45-degree field of view, 1932 by 1916 pixels: 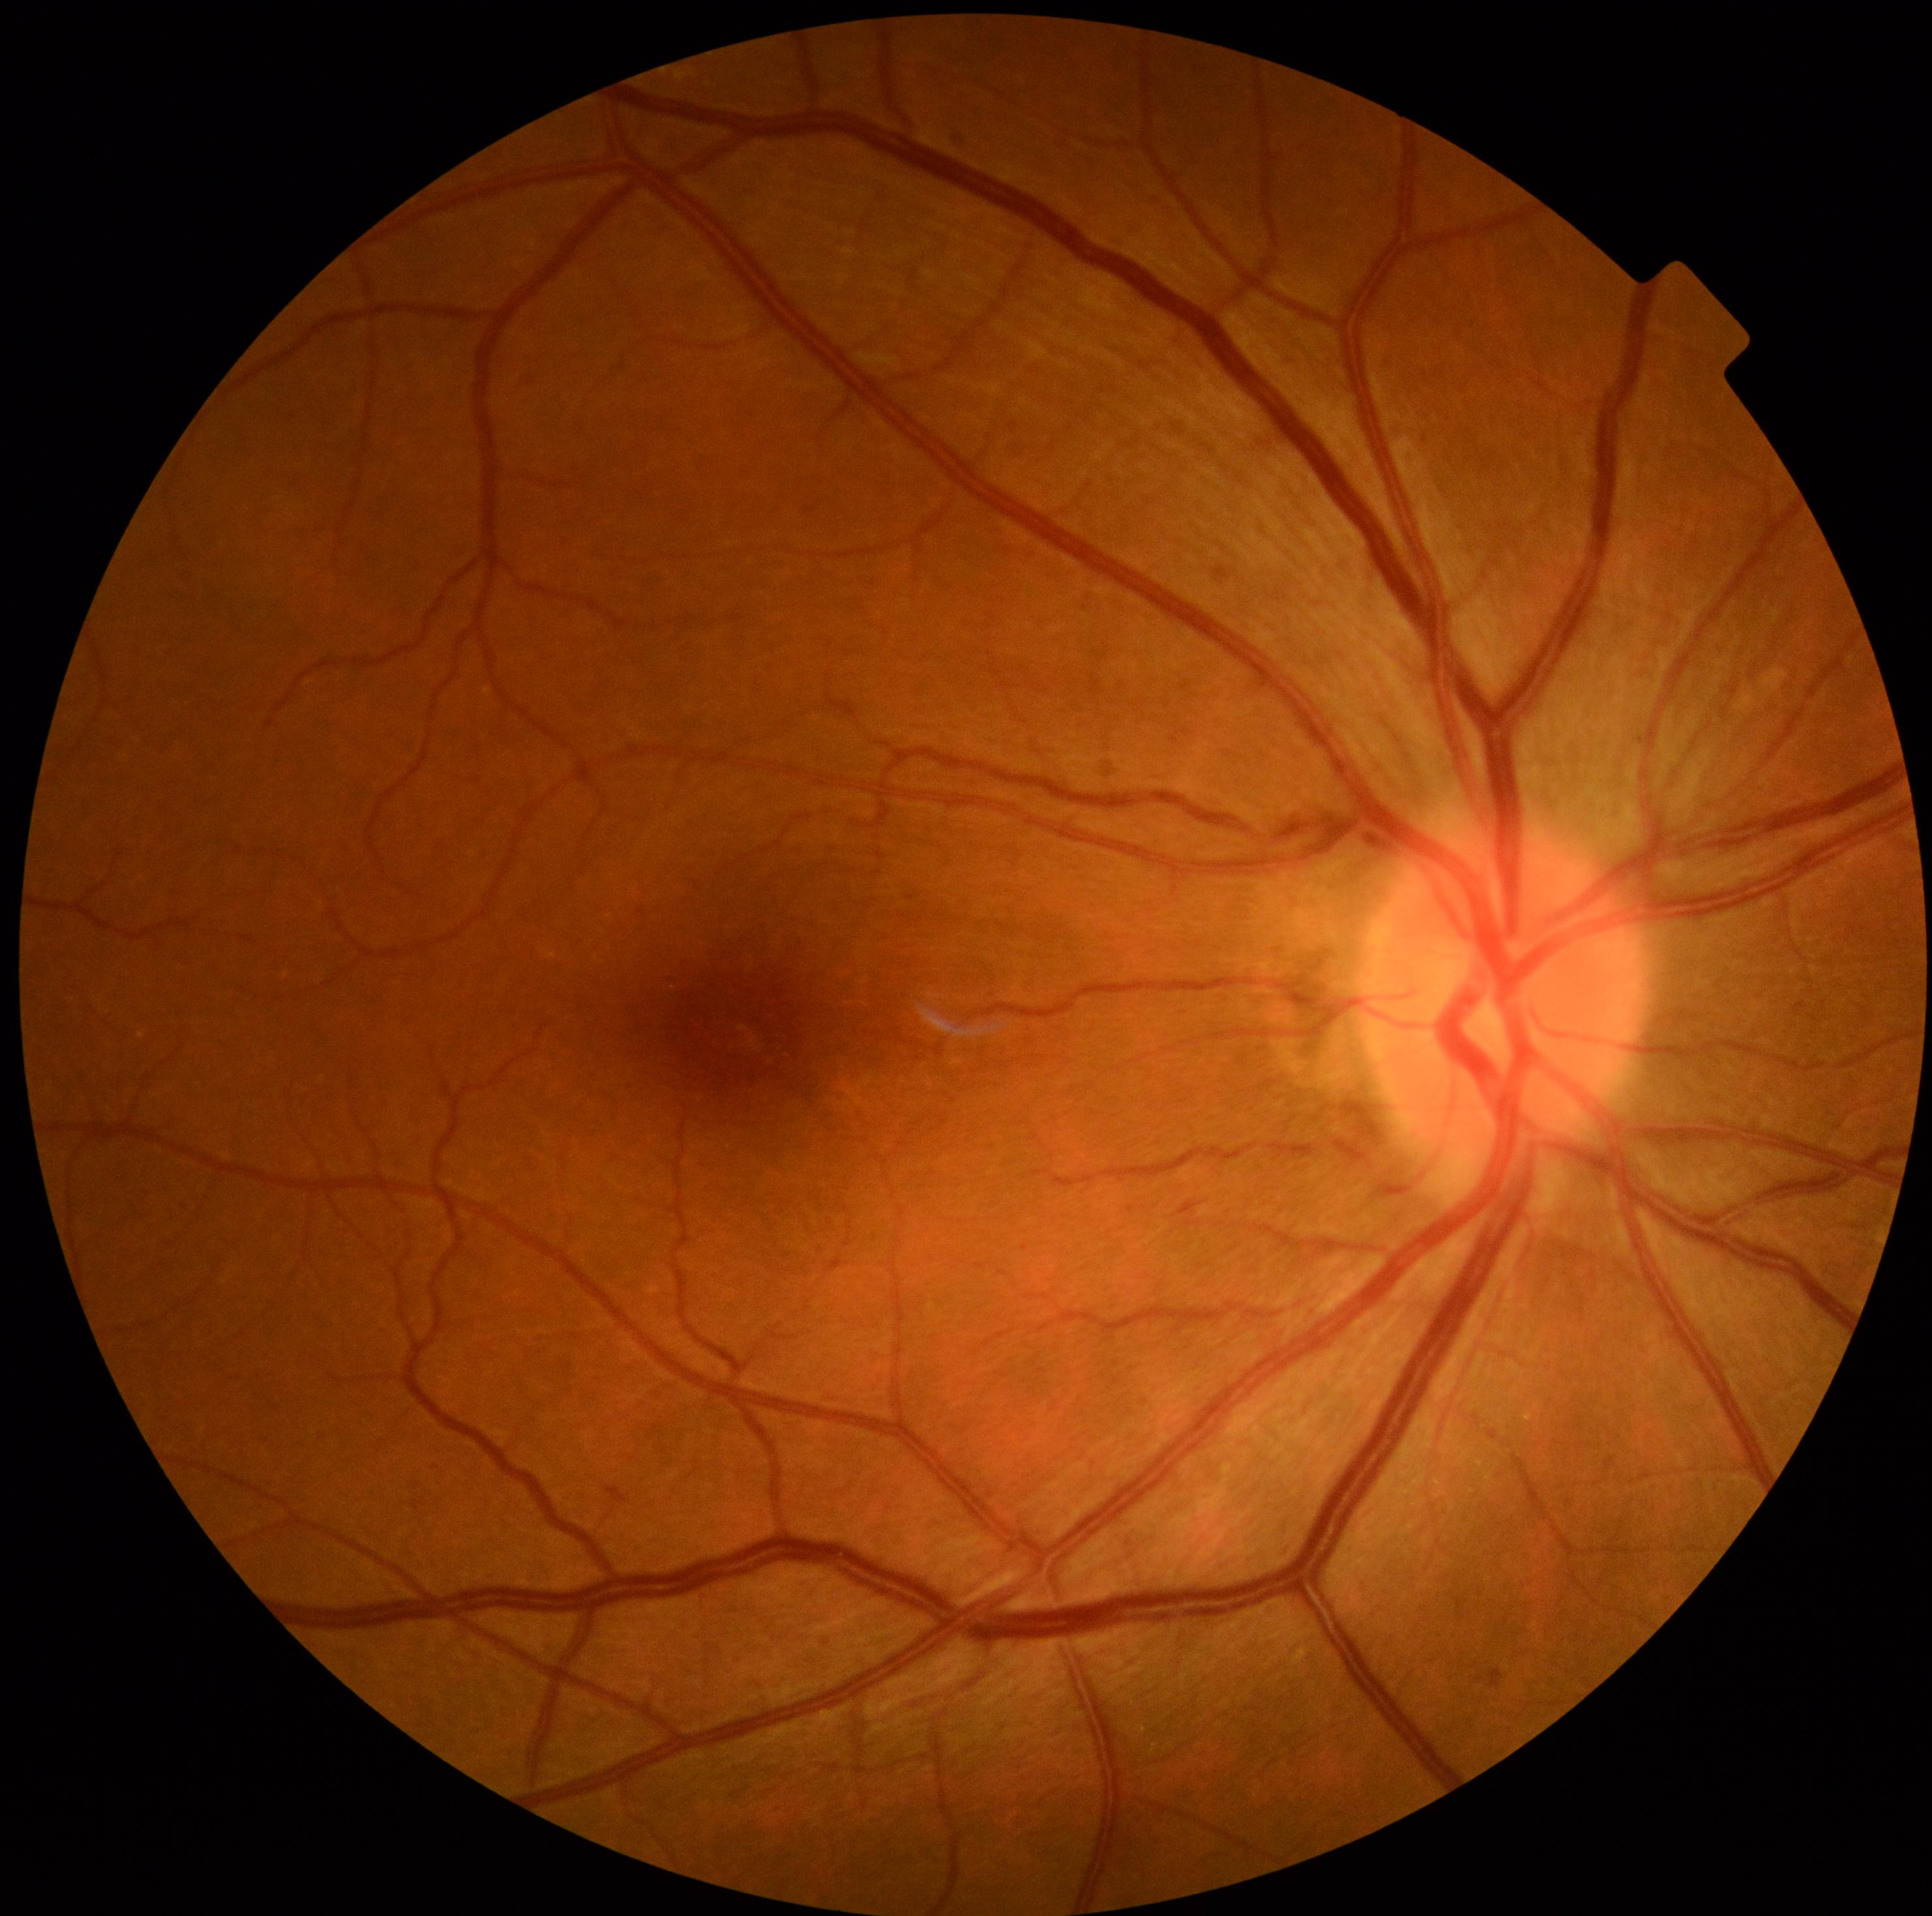
Diabetic retinopathy: grade 2.